Fundus photograph cropped around the optic nerve head. 340x340px. Captured with pupil dilation.
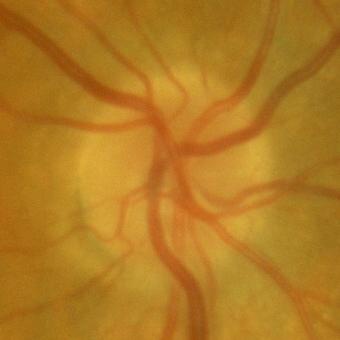

Showing no glaucomatous optic neuropathy.